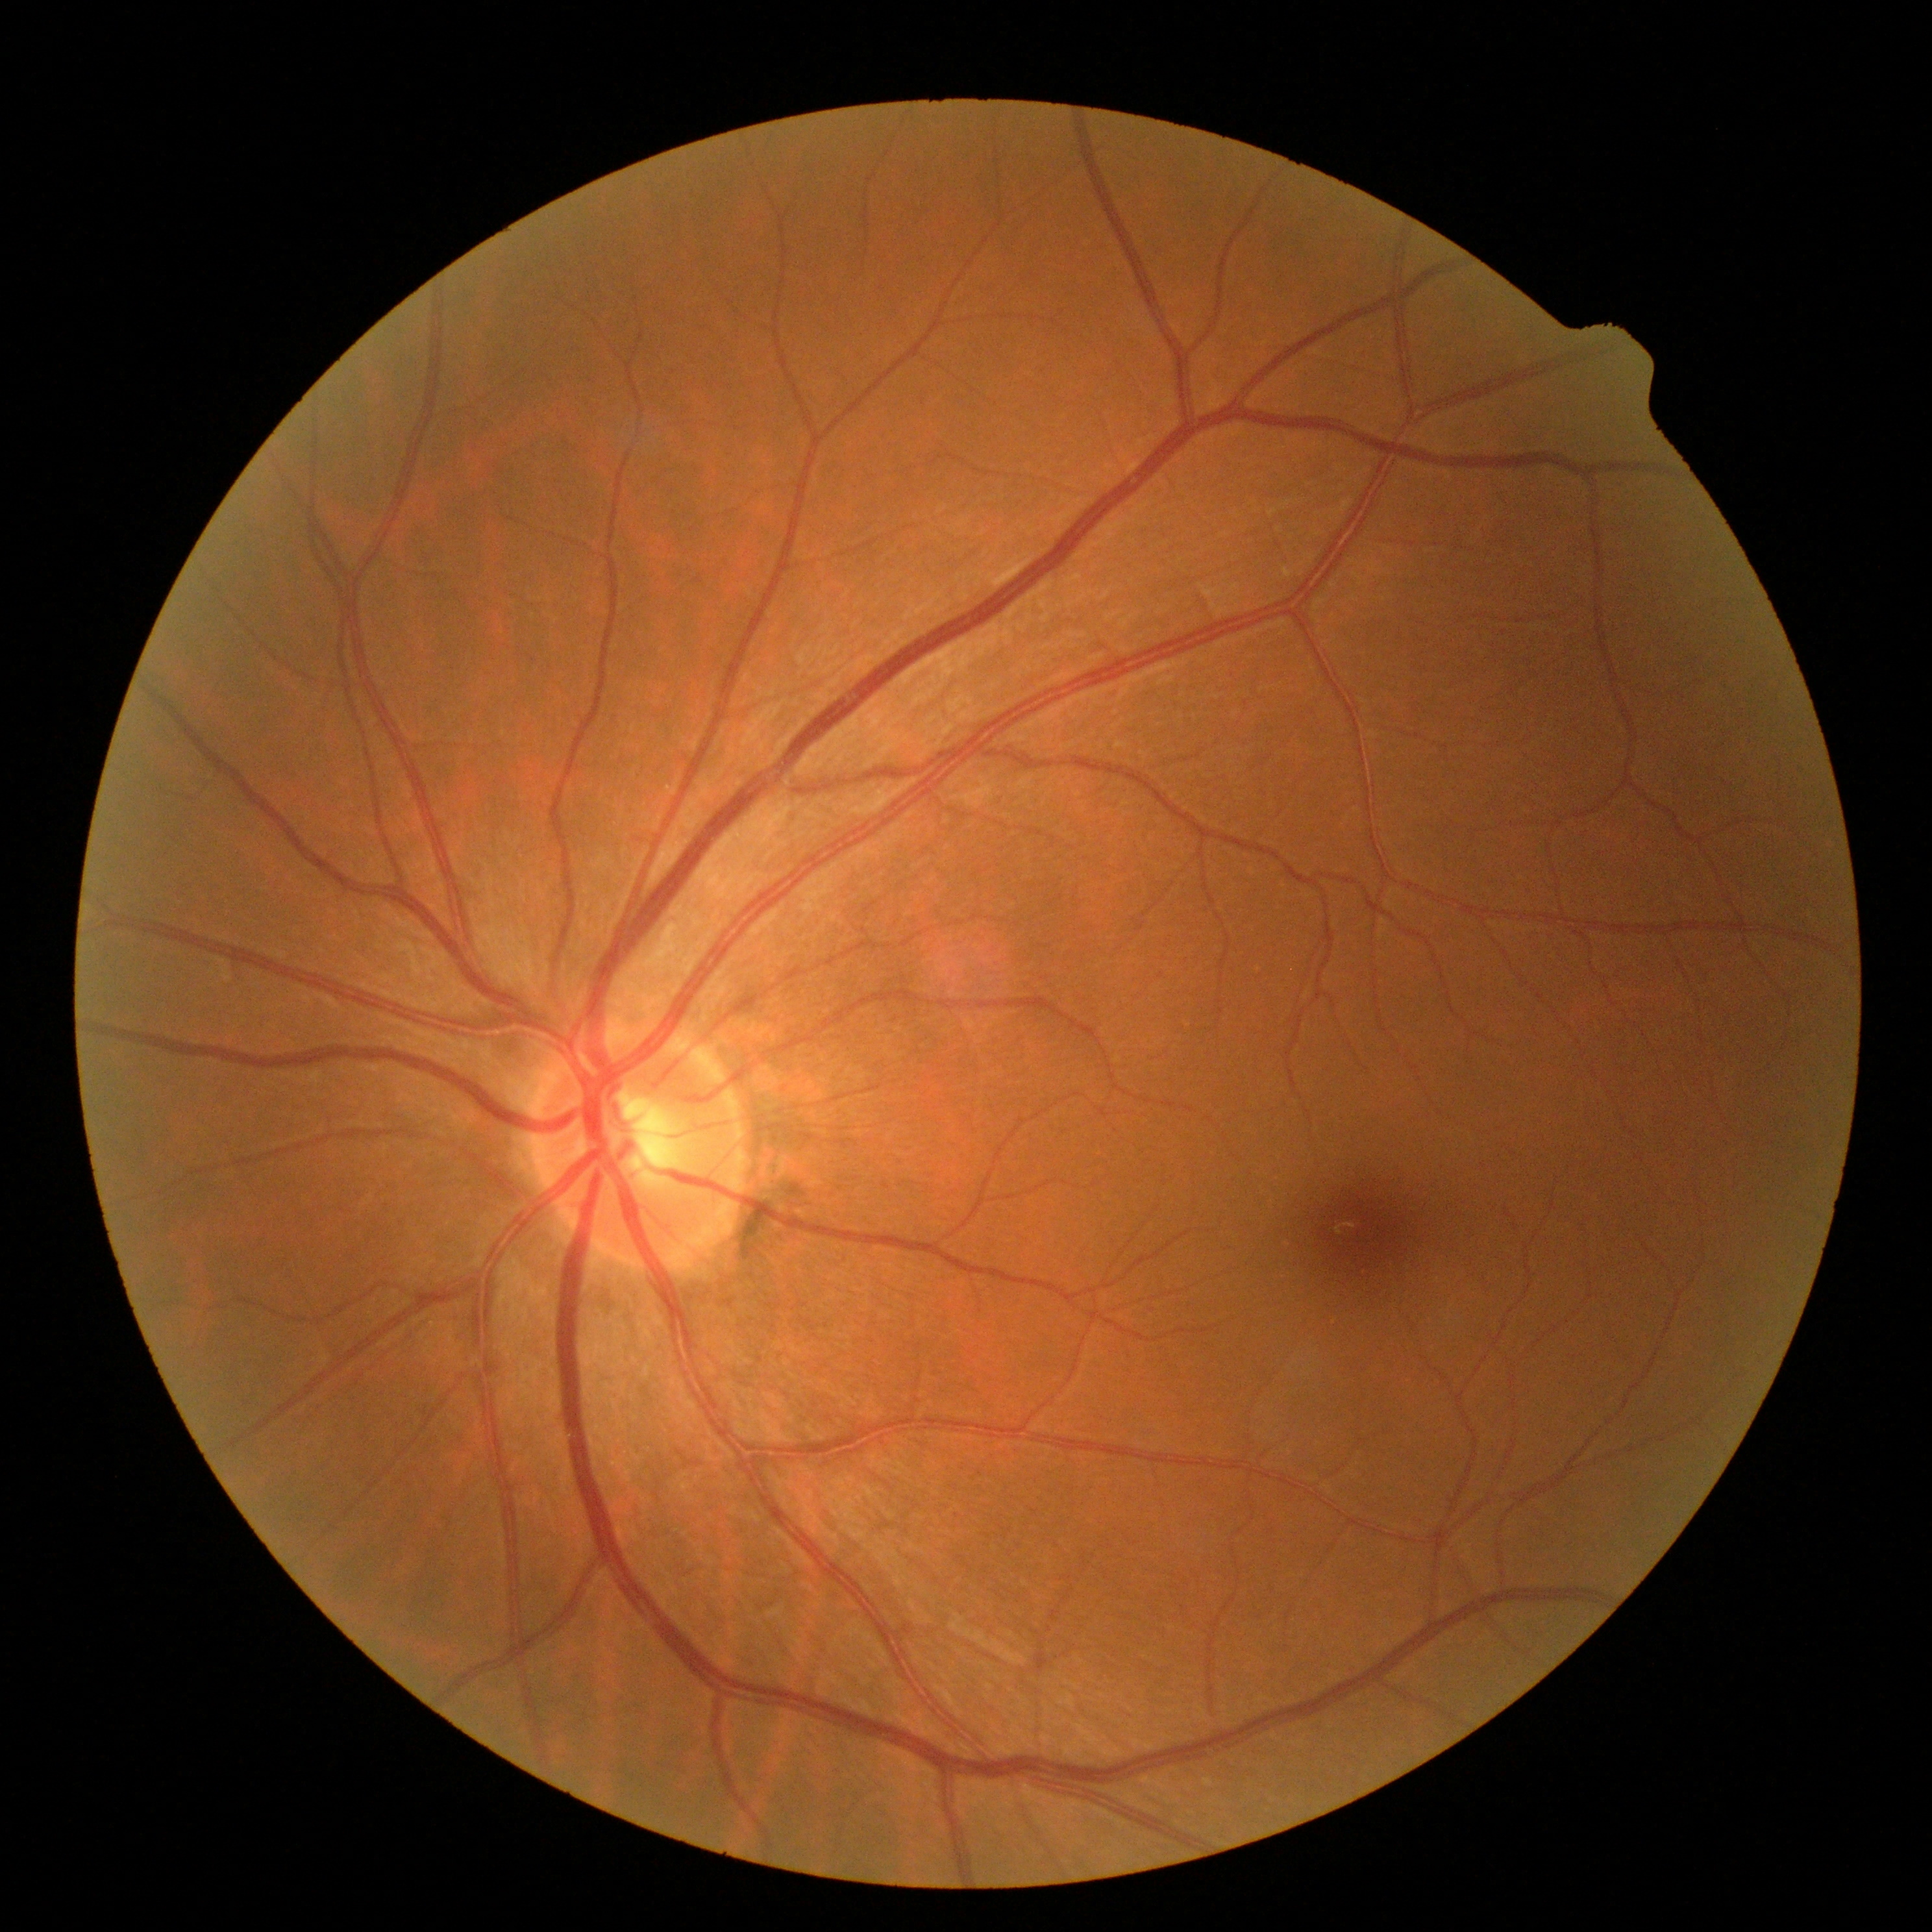
DR = grade 0 — no visible signs of diabetic retinopathy; DR impression = no signs of DR.